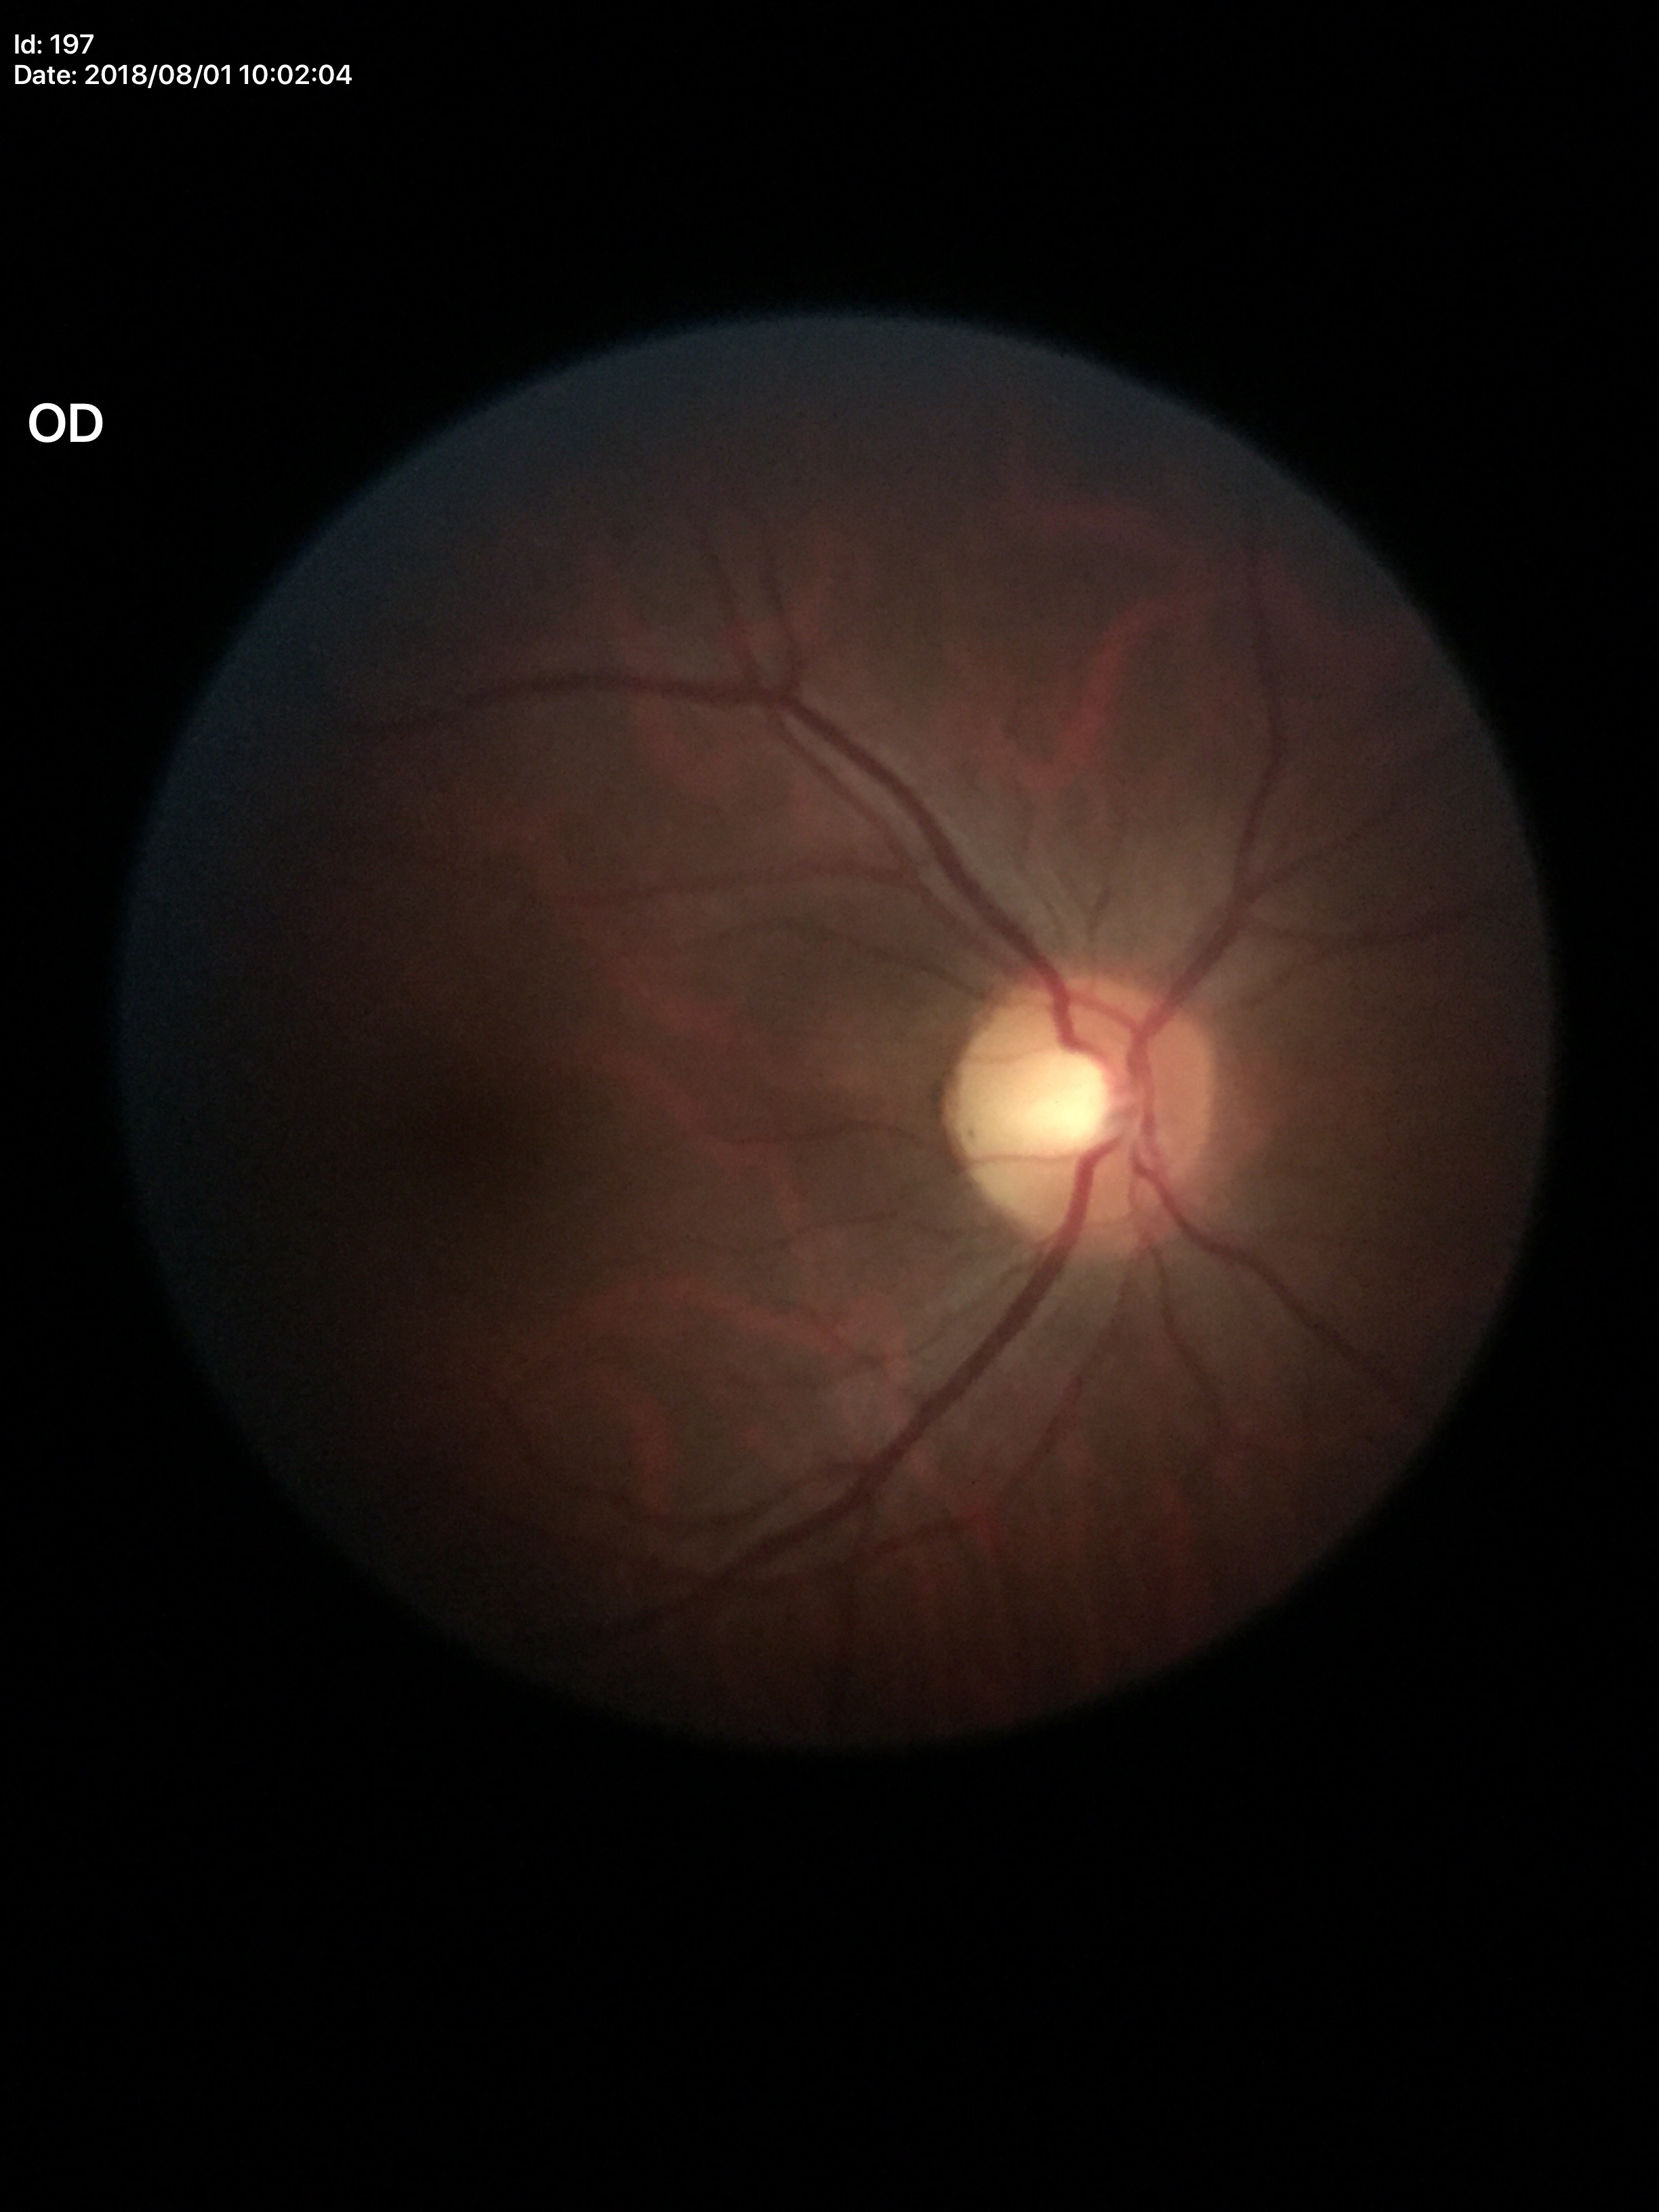 Negative for glaucoma suspicion (5/5 ophthalmologists in agreement). VCDR of 0.46. HCDR is 0.50.